45° FOV; 848 x 848 pixels — 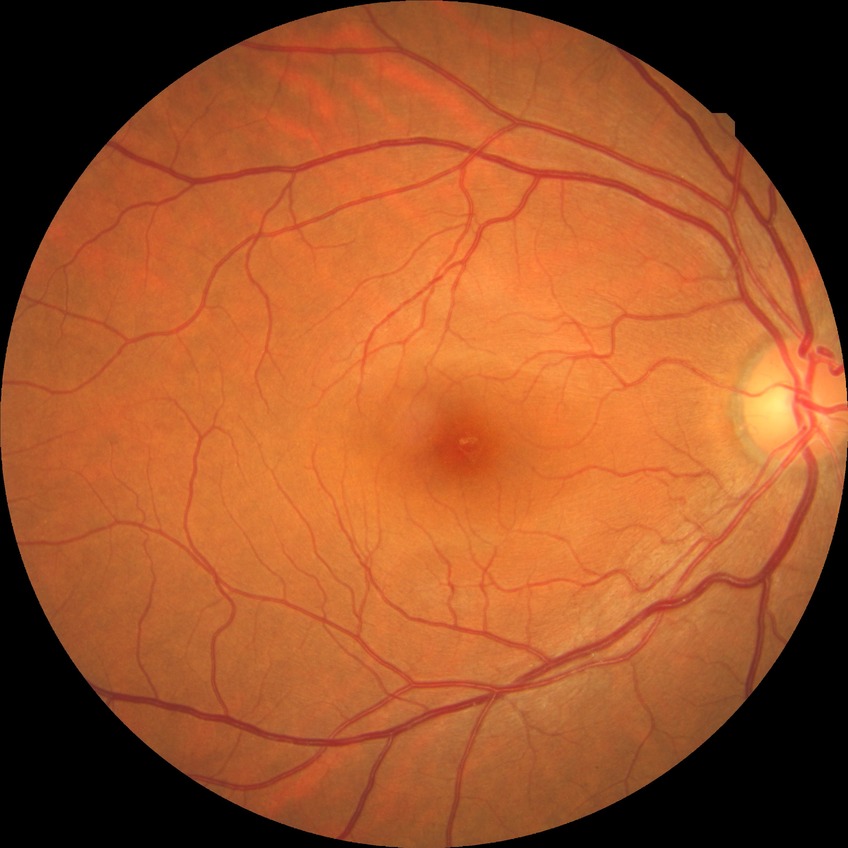

Modified Davis grading is no diabetic retinopathy.